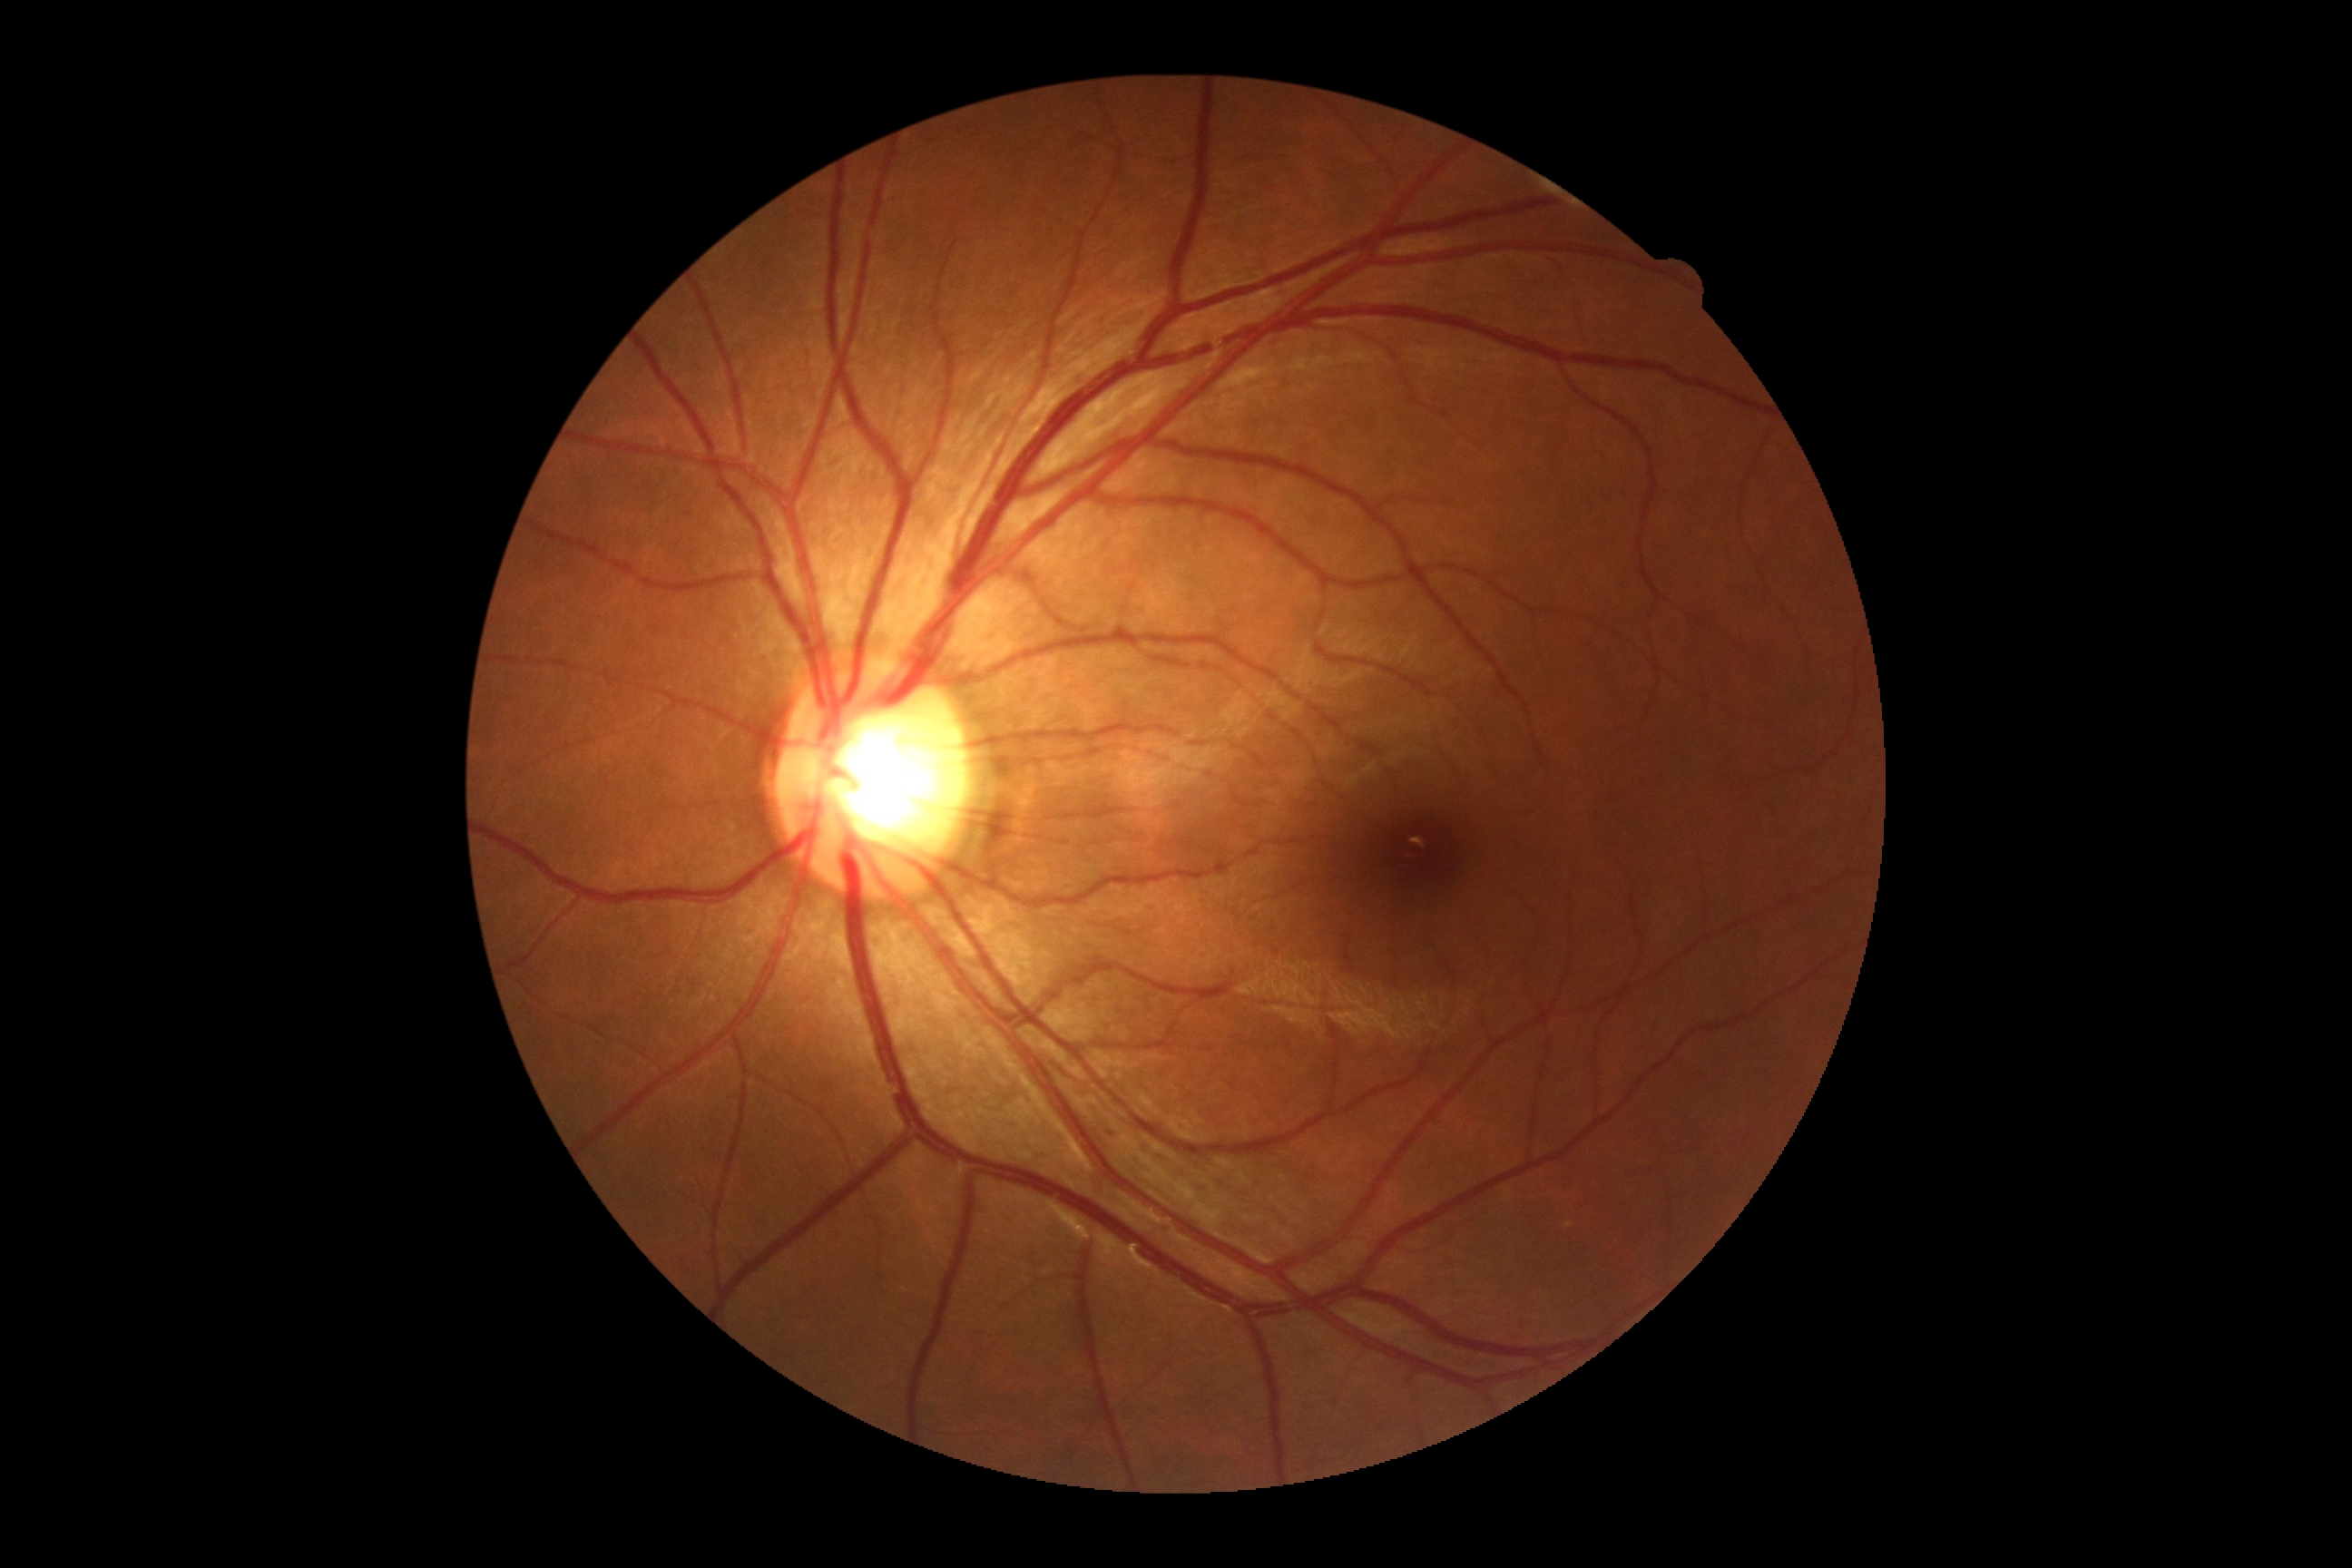
DR severity is 0.